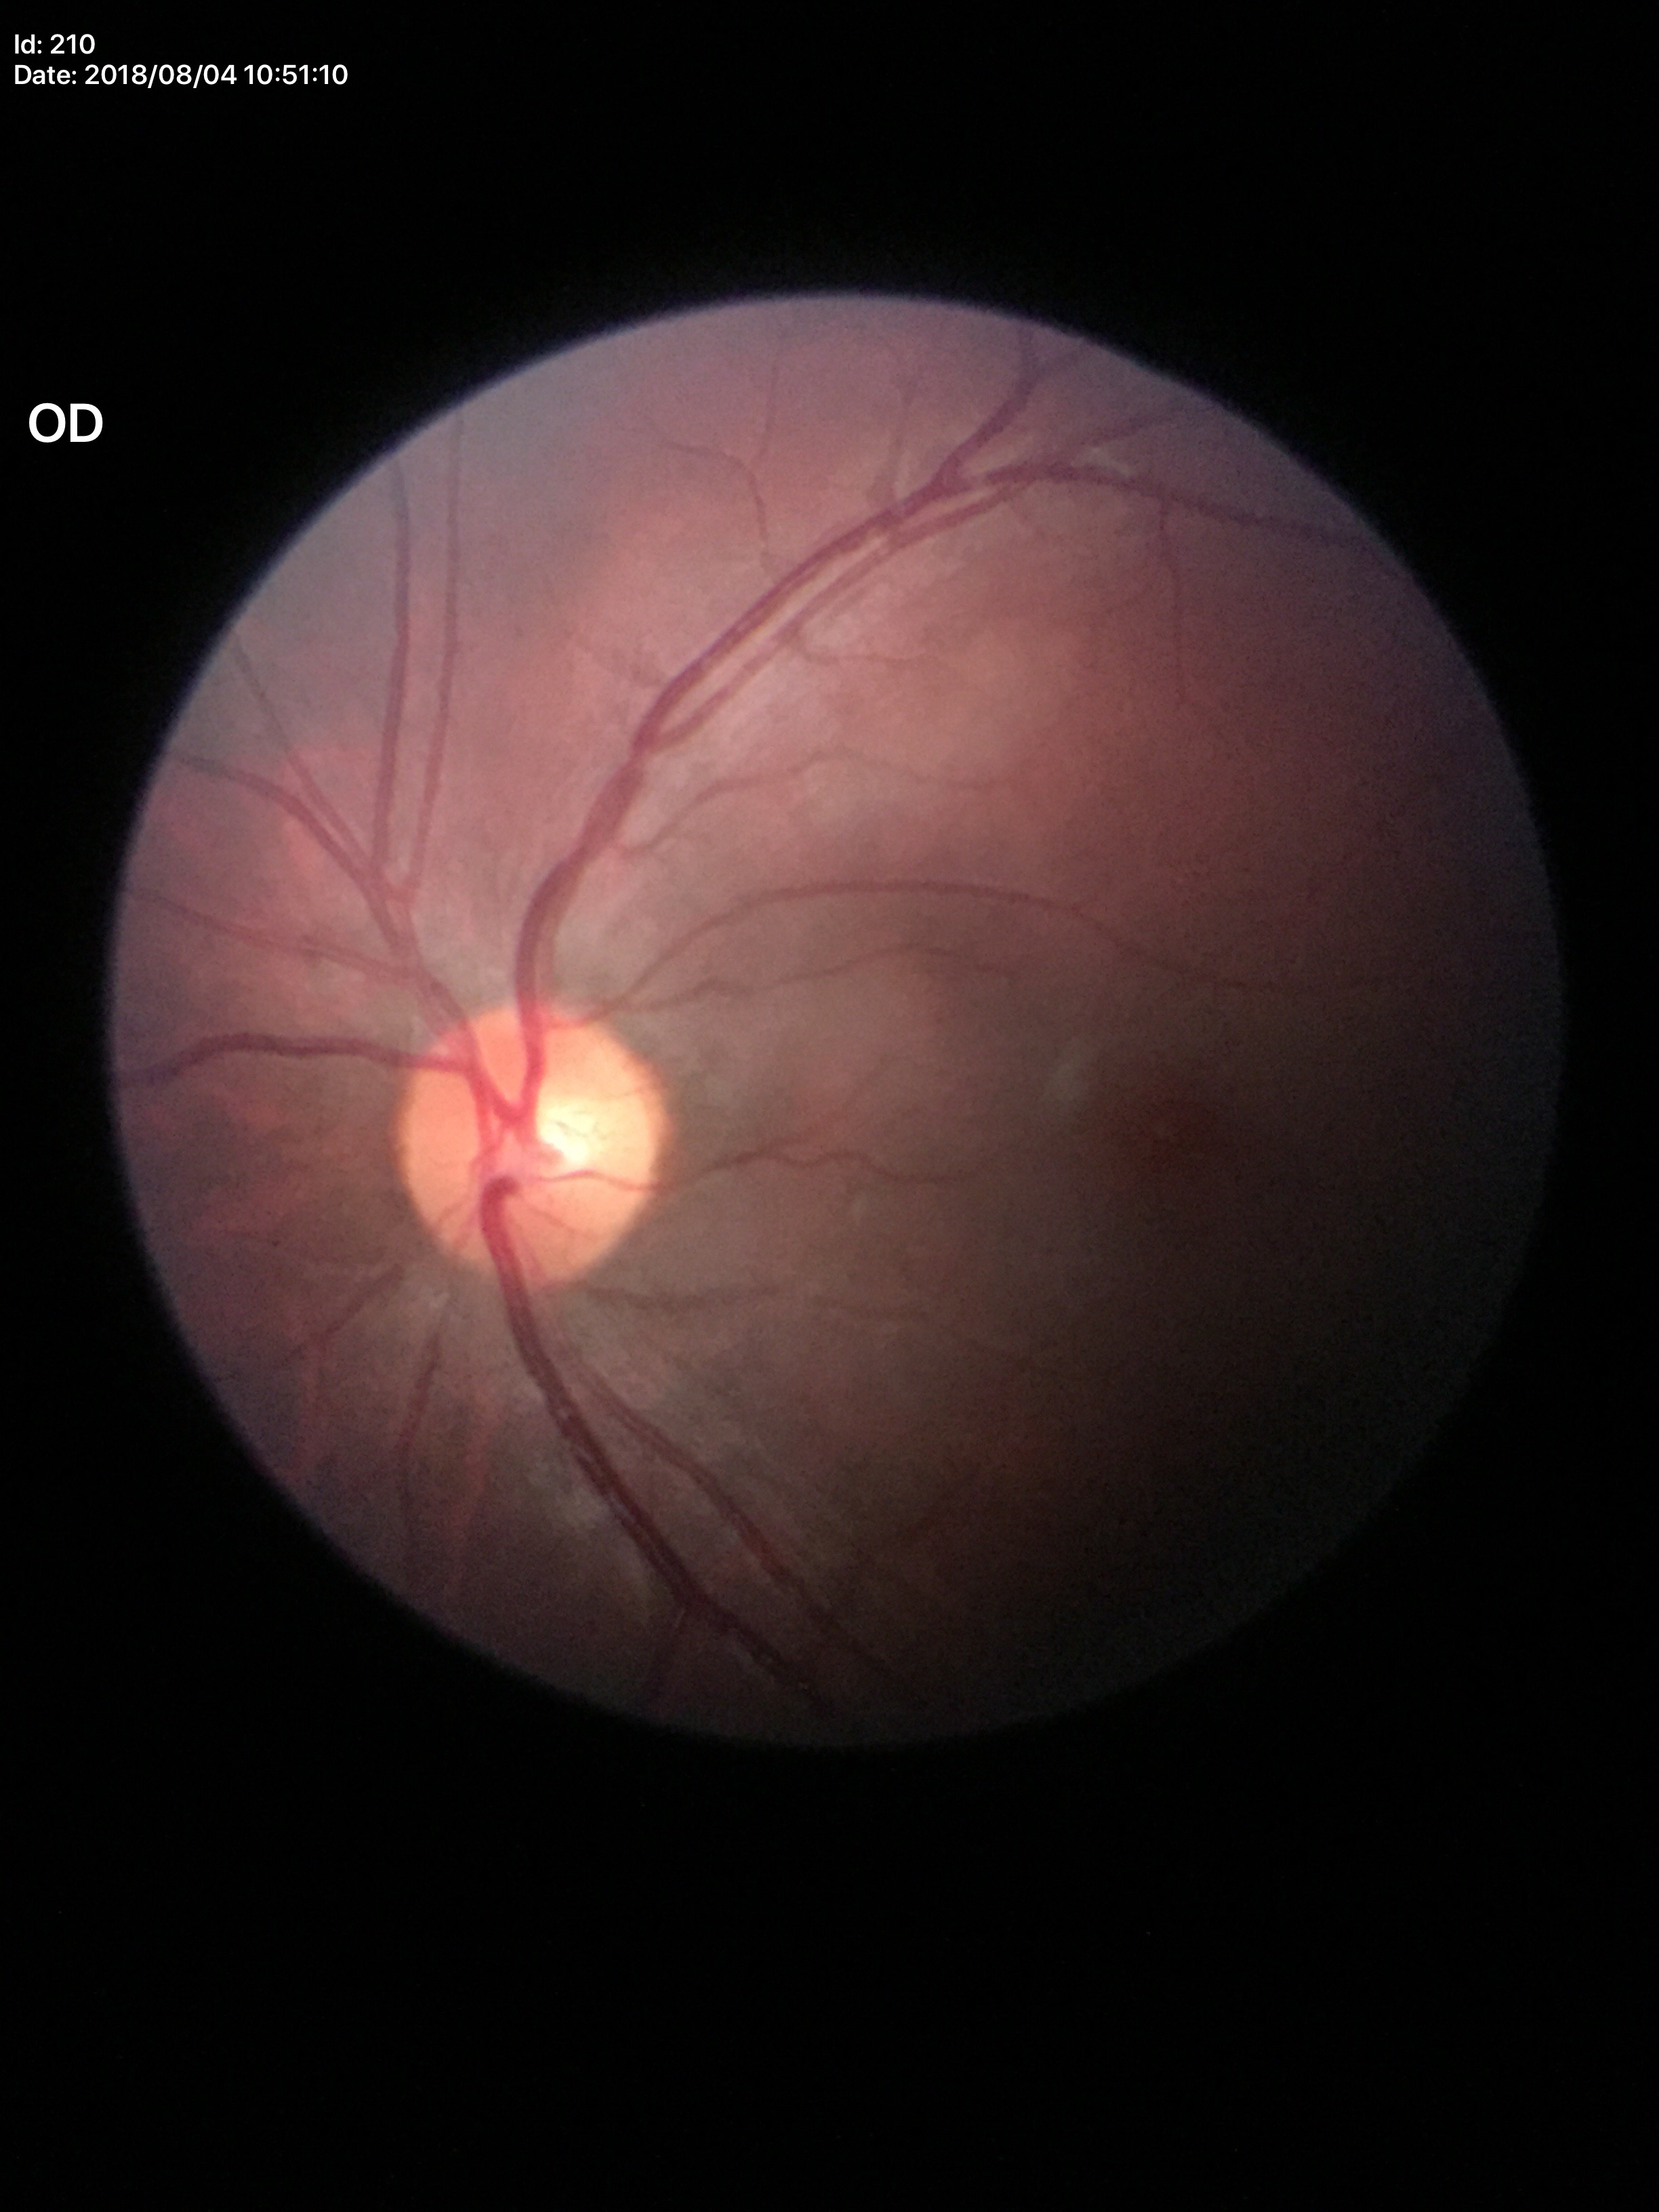 {"glaucoma_decision": "no suspicious findings", "vcdr": "0.46", "hcdr": "0.53"}